2352 by 1568 pixels; 45° field of view; fundus photo:
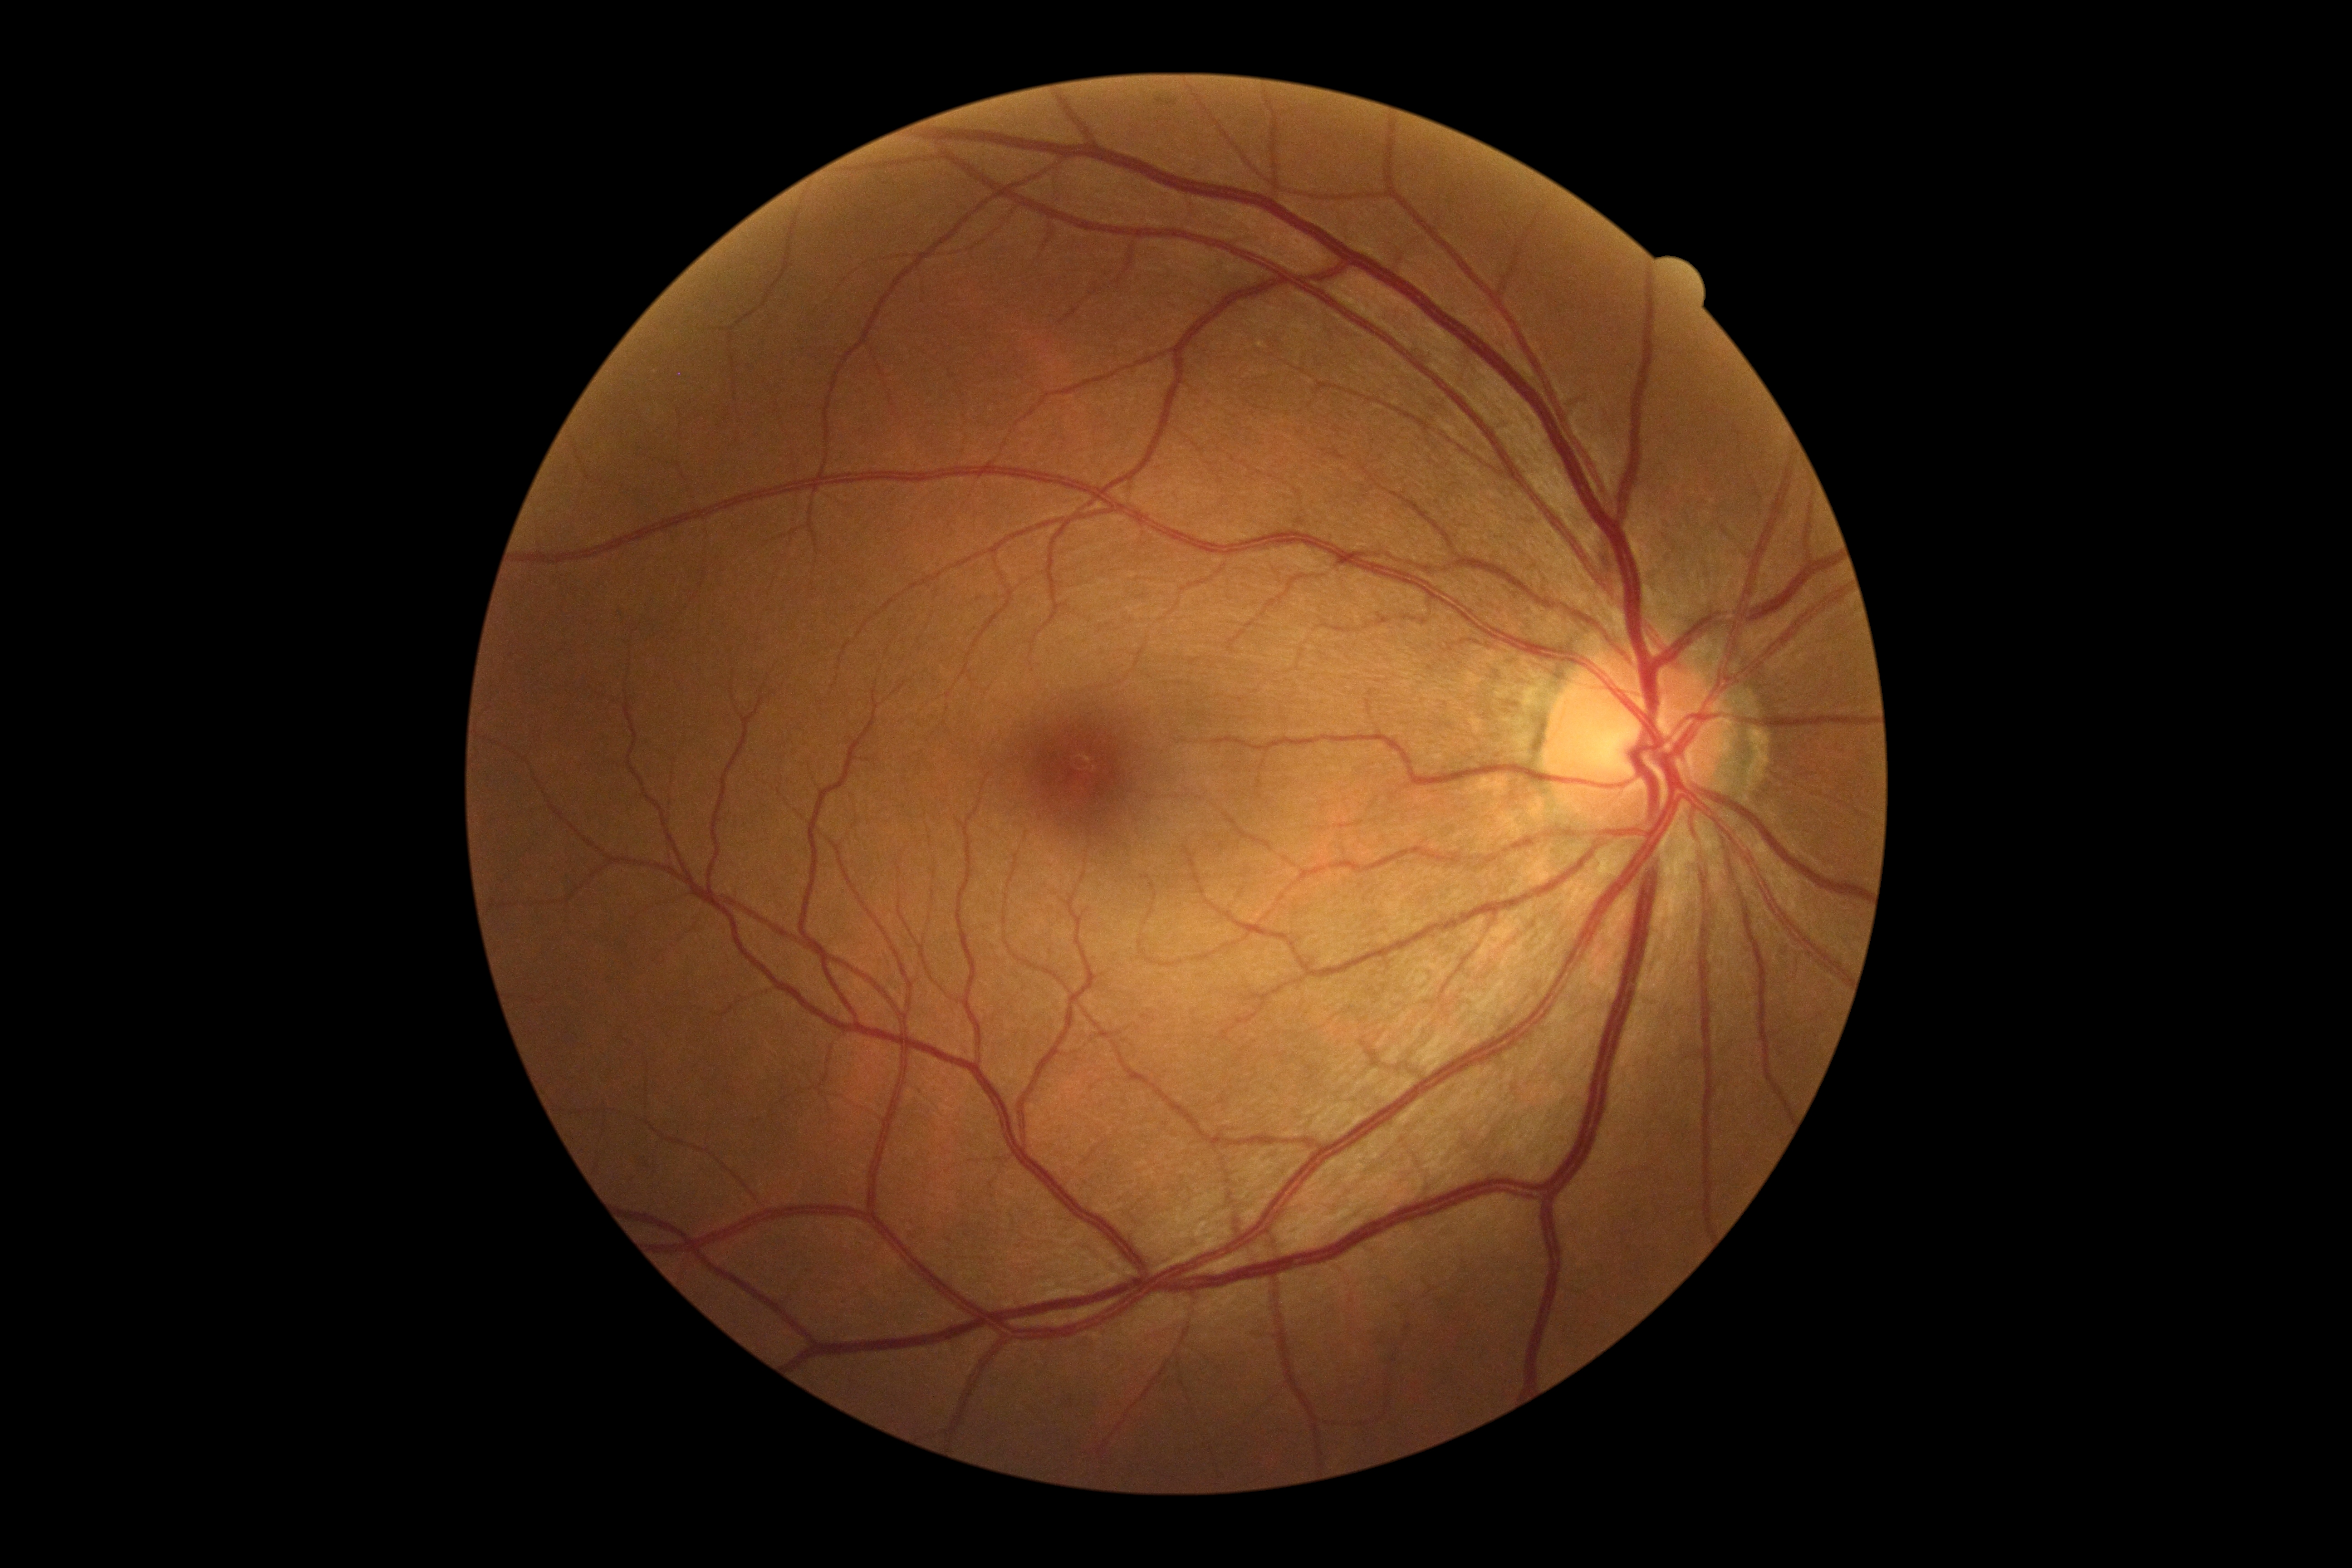
No signs of diabetic retinopathy.
Diabetic retinopathy: 0/4.